412x310px, tabletop color fundus camera image, 45° field of view
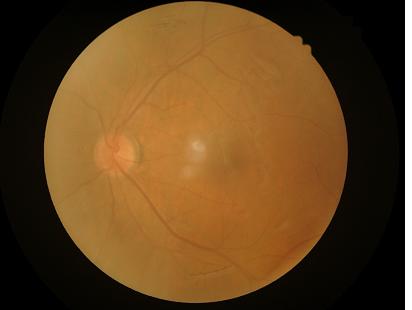 Reduced sharpness with visible blur. Overall image quality is poor. Contrast is low. No over- or under-exposure.